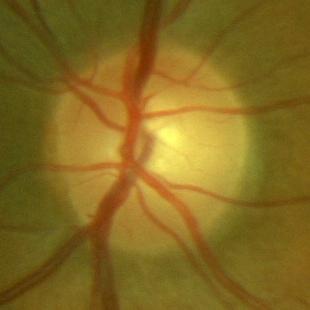 Glaucoma status: no glaucoma.